Retinal fundus photograph; 2352 x 1568 pixels — 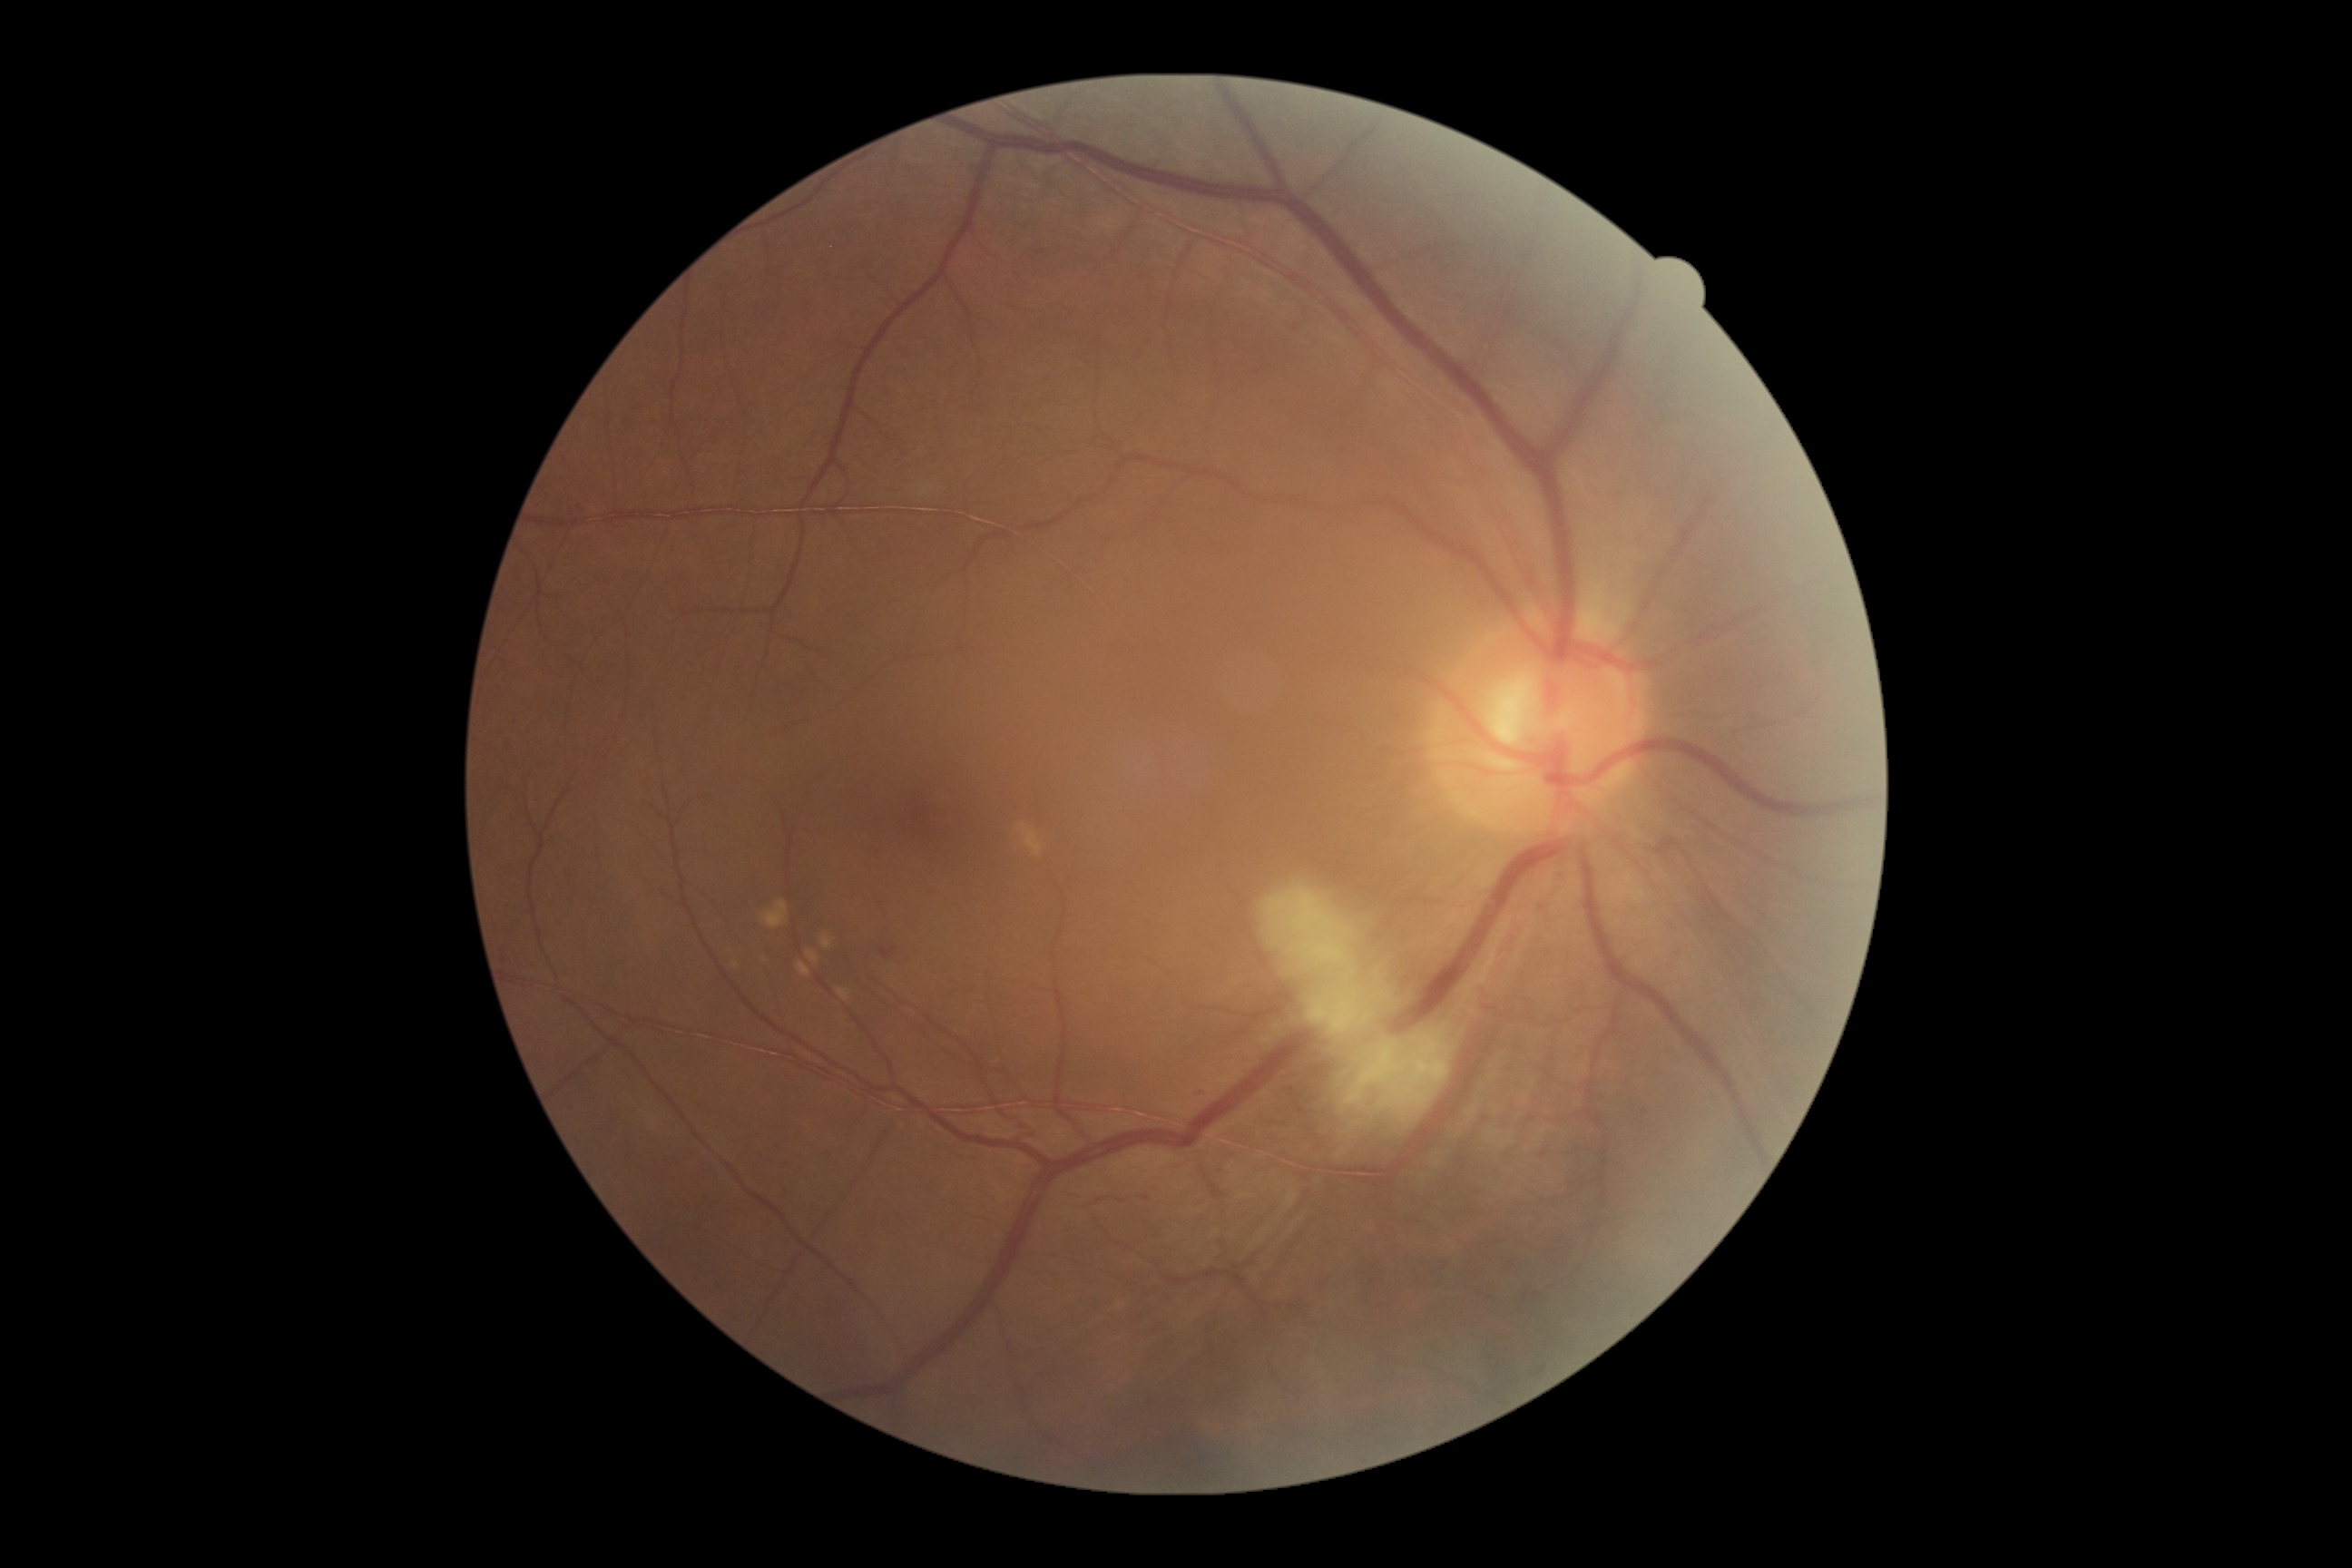
Diabetic retinopathy: grade 2 (moderate NPDR) — more than just microaneurysms but less than severe NPDR.